Color fundus photograph. 2352x1568. 45° field of view — 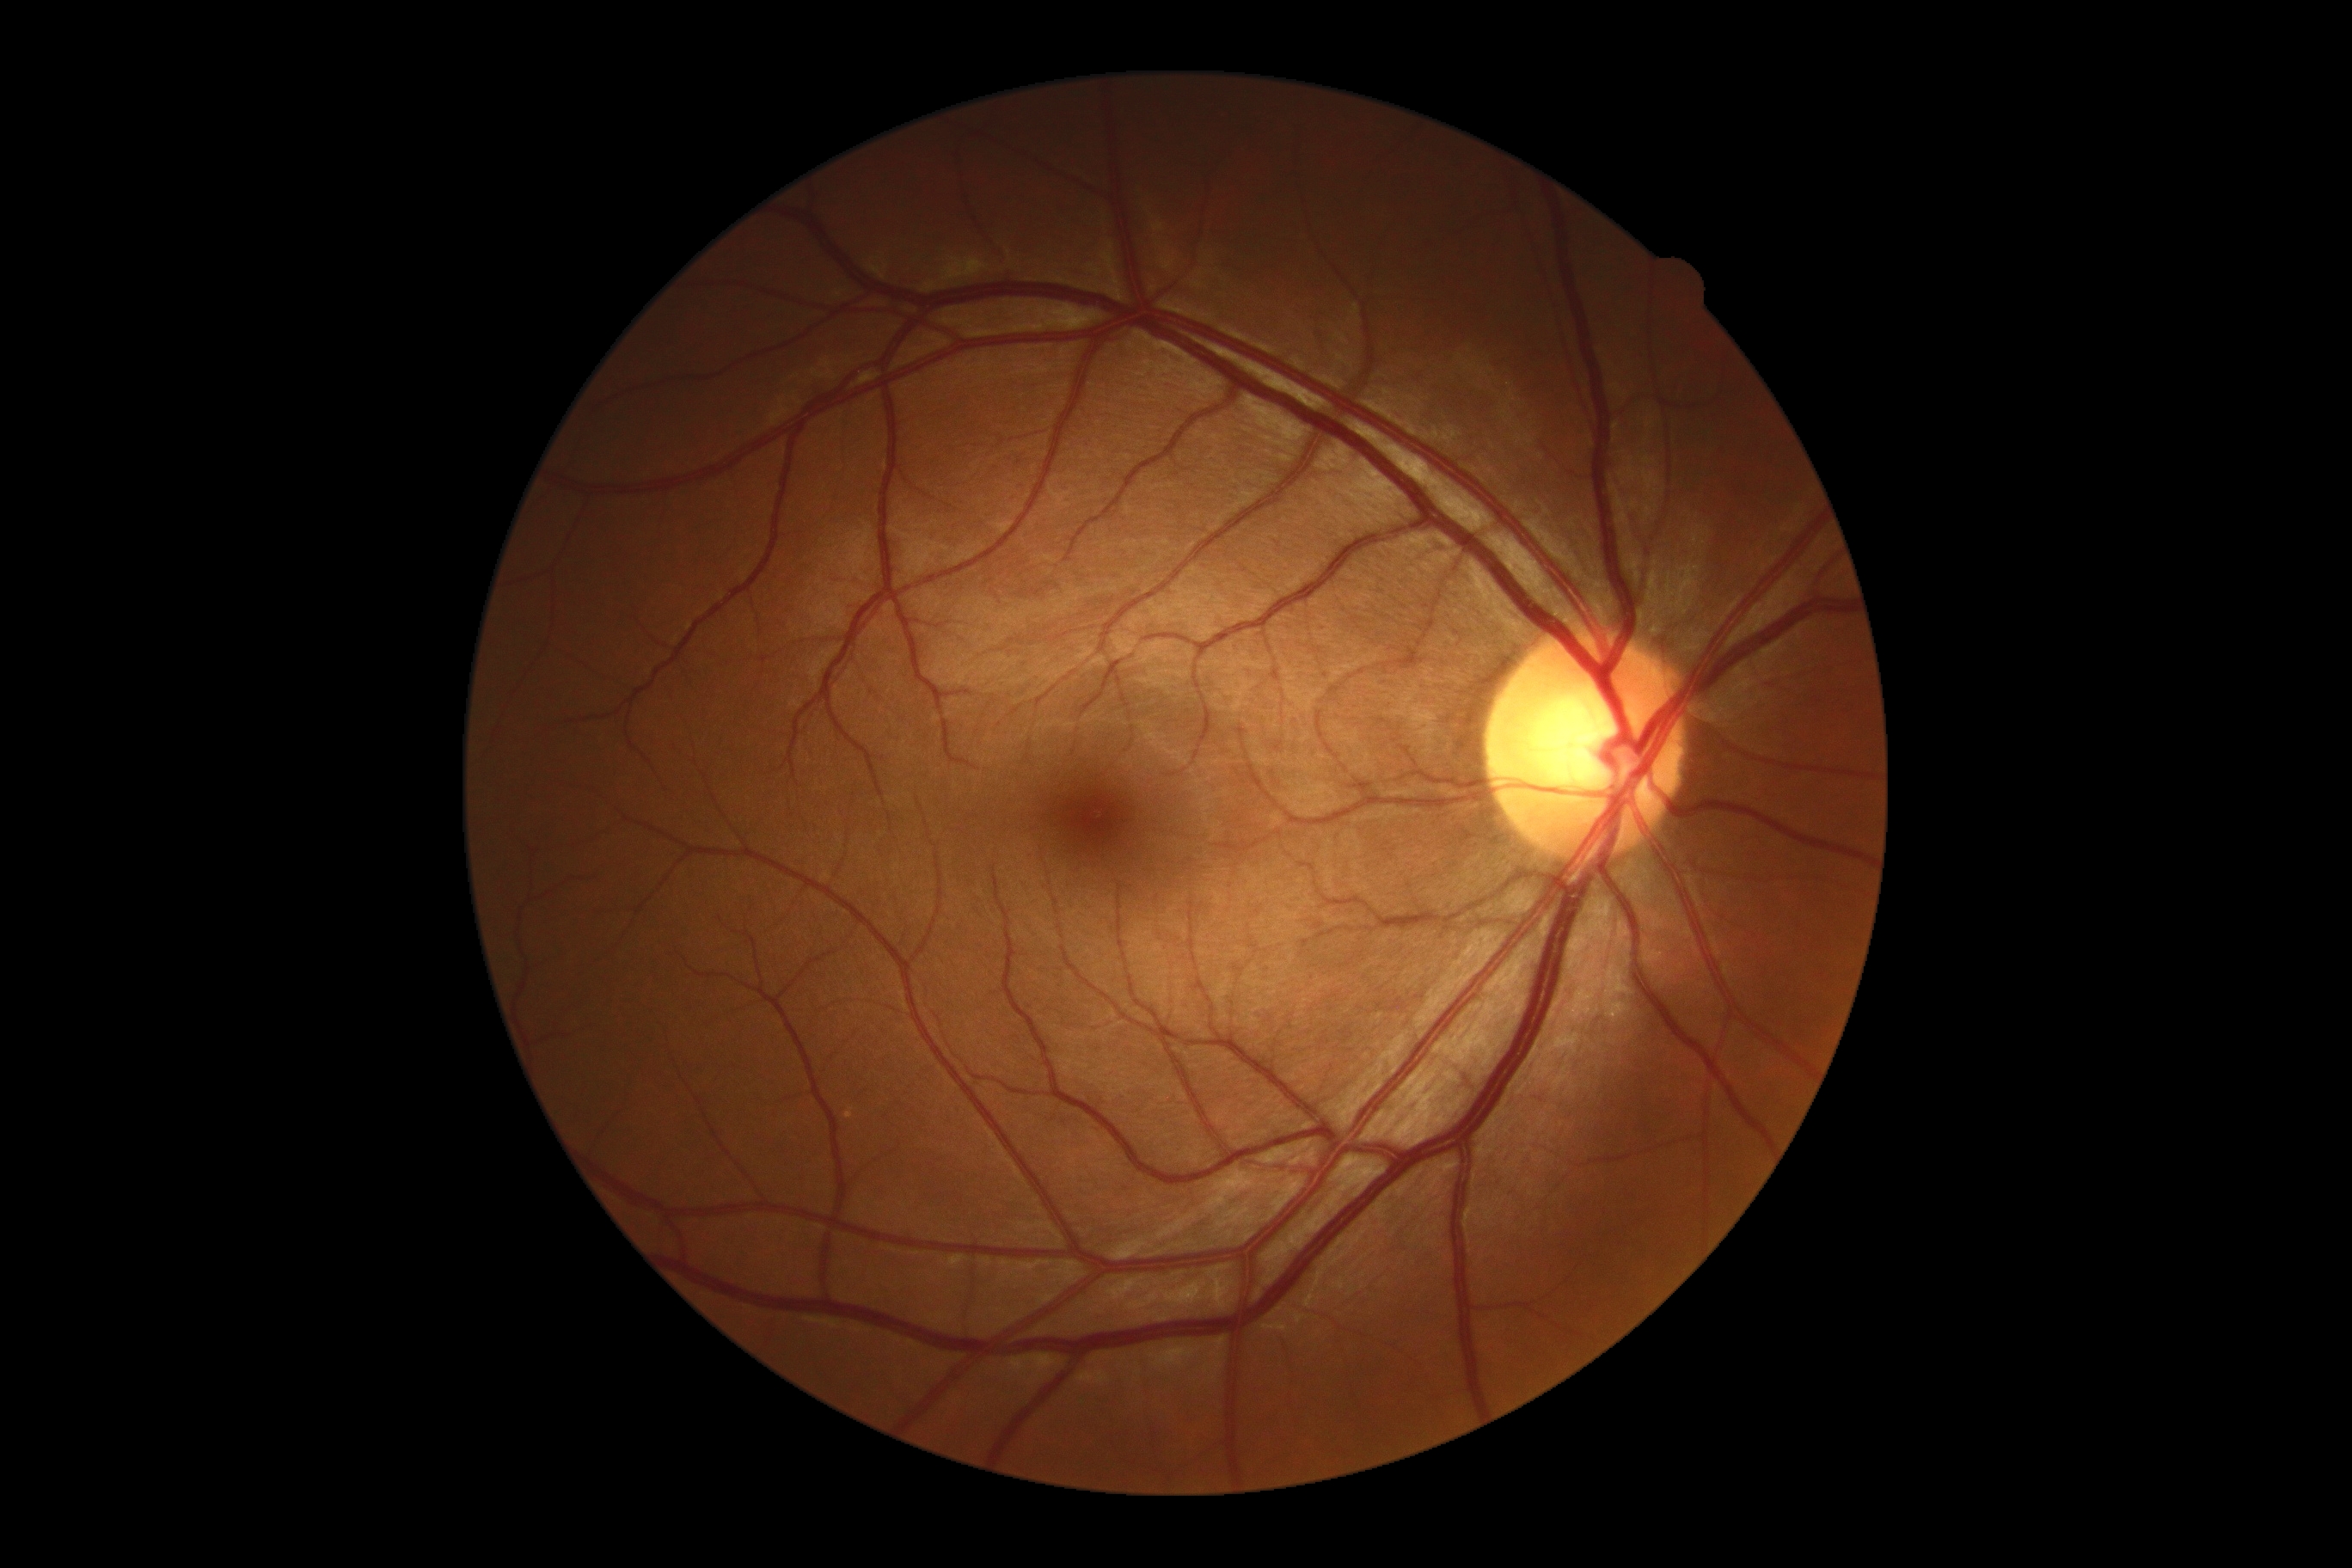 No diabetic retinal disease findings. Diabetic retinopathy (DR) is 0.